45° FOV · fundus photo · 2352 by 1568 pixels.
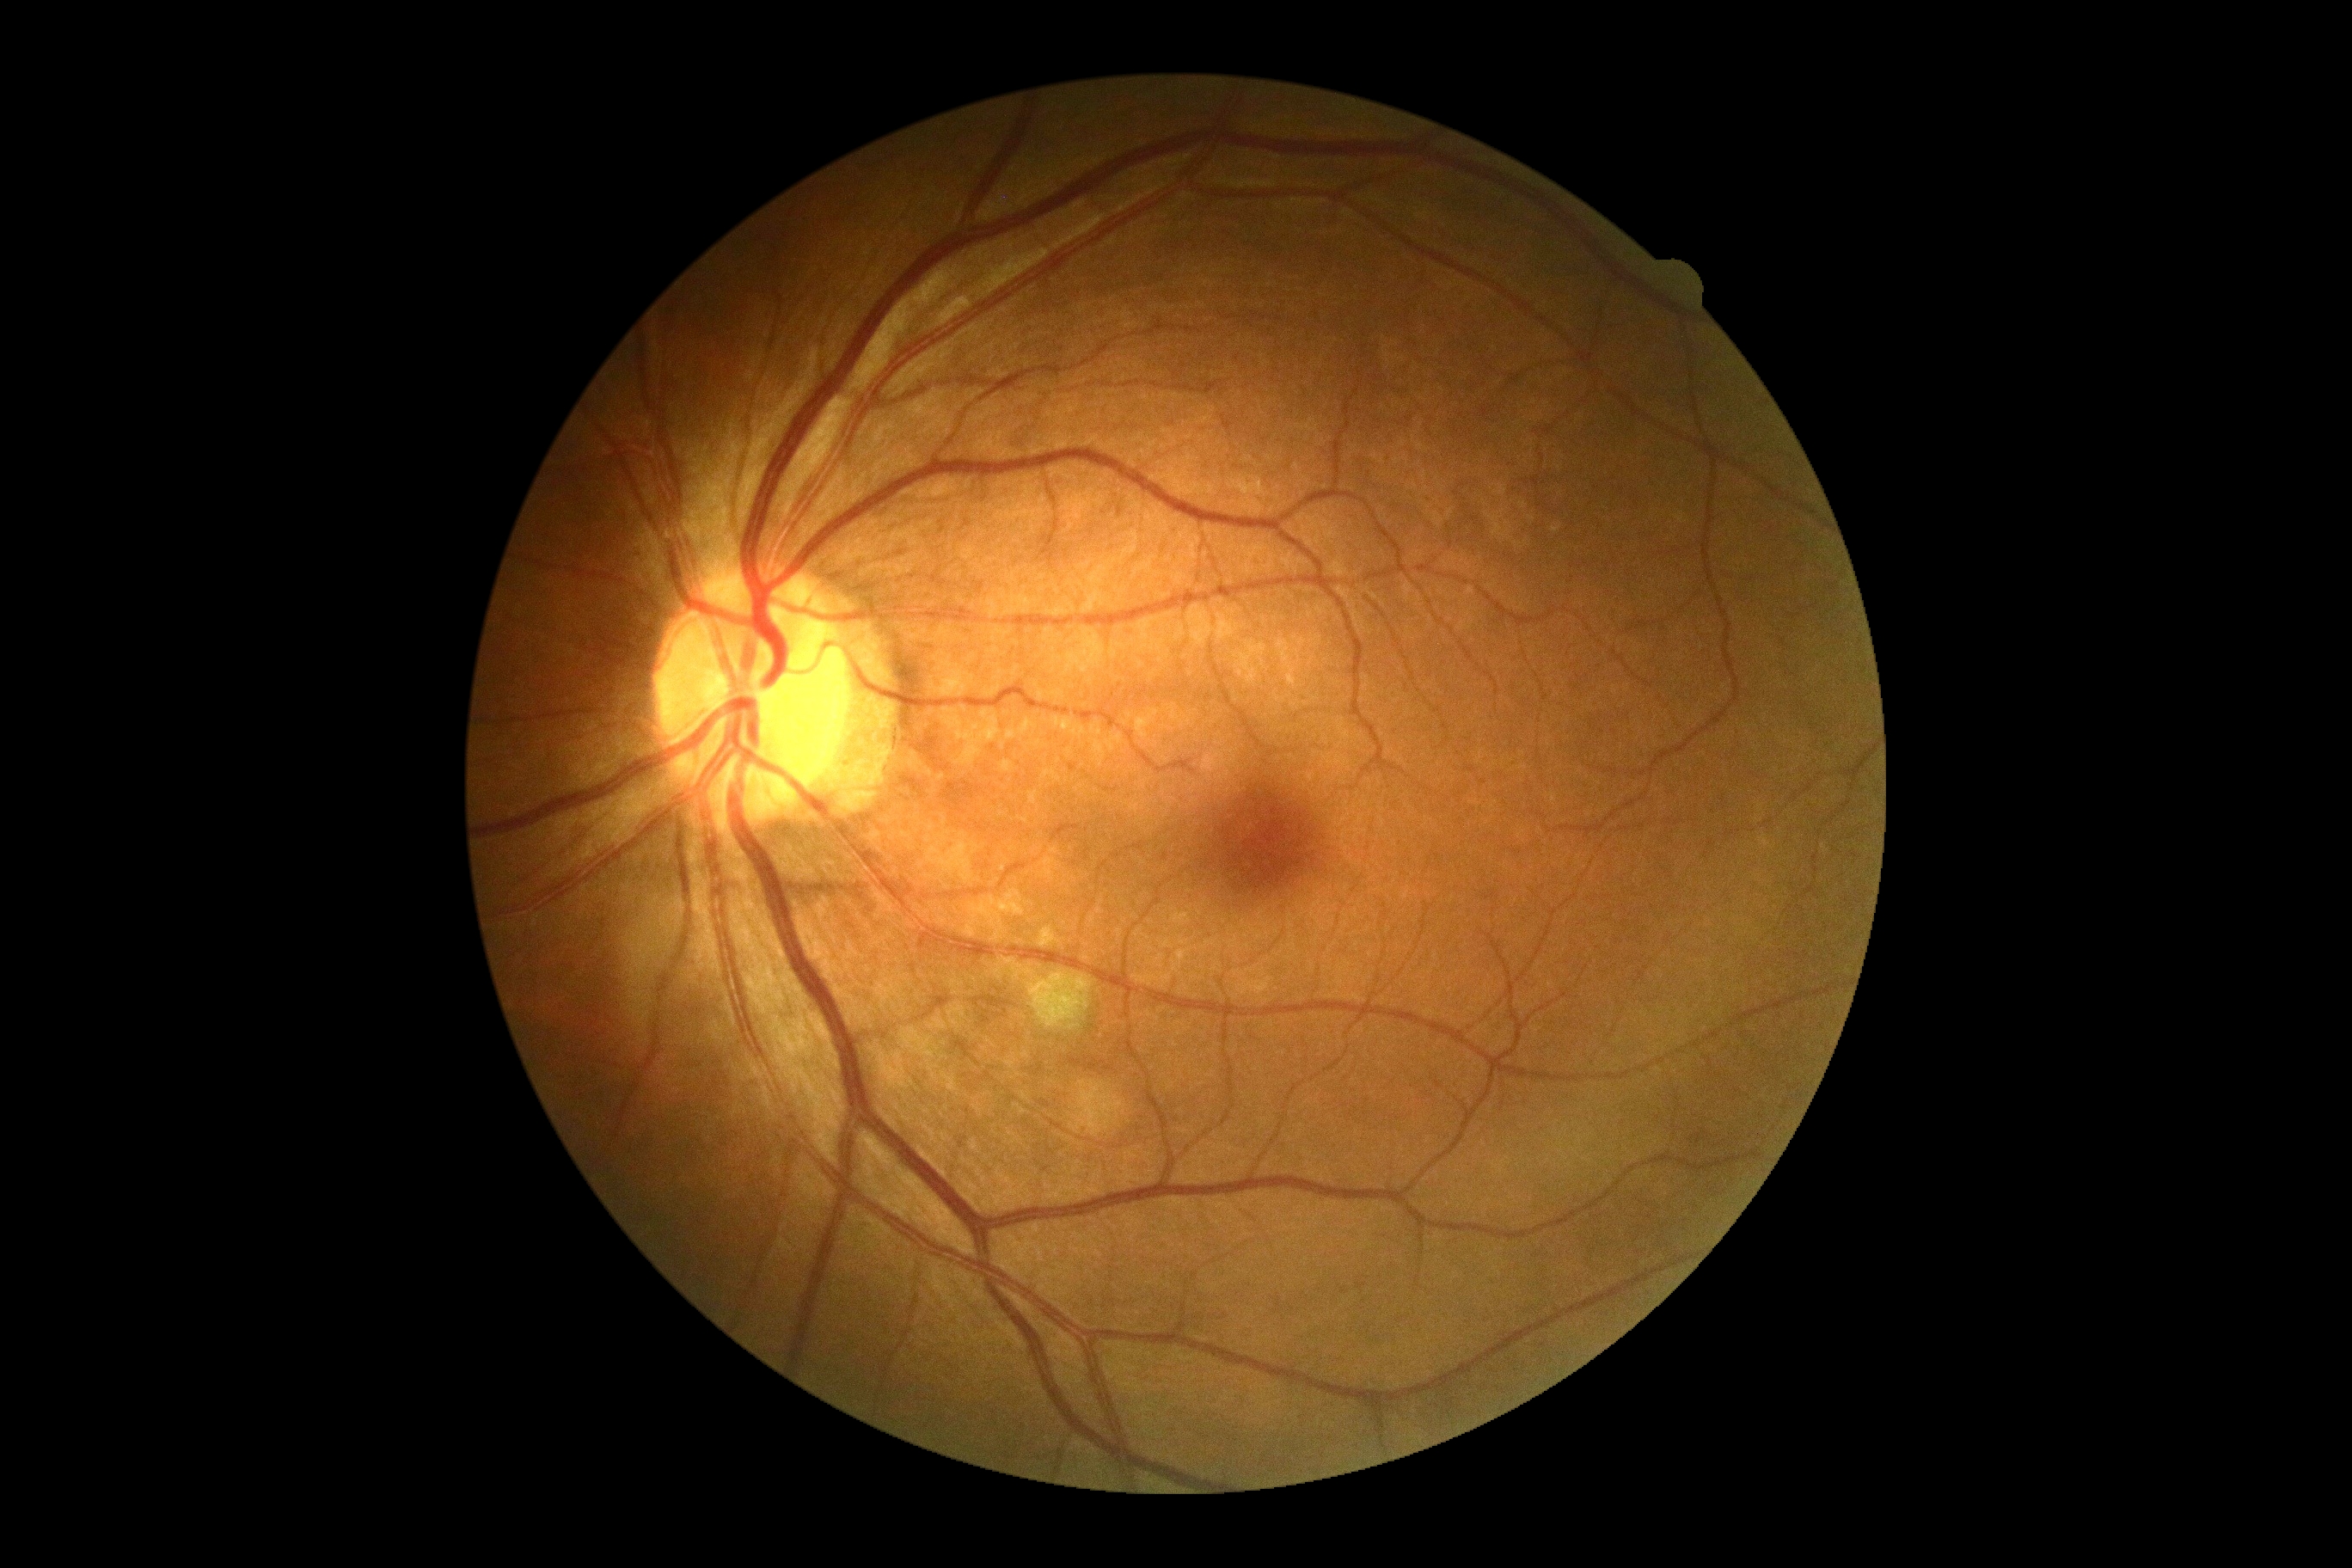 No apparent diabetic retinopathy.
DR grade is no apparent diabetic retinopathy (0).